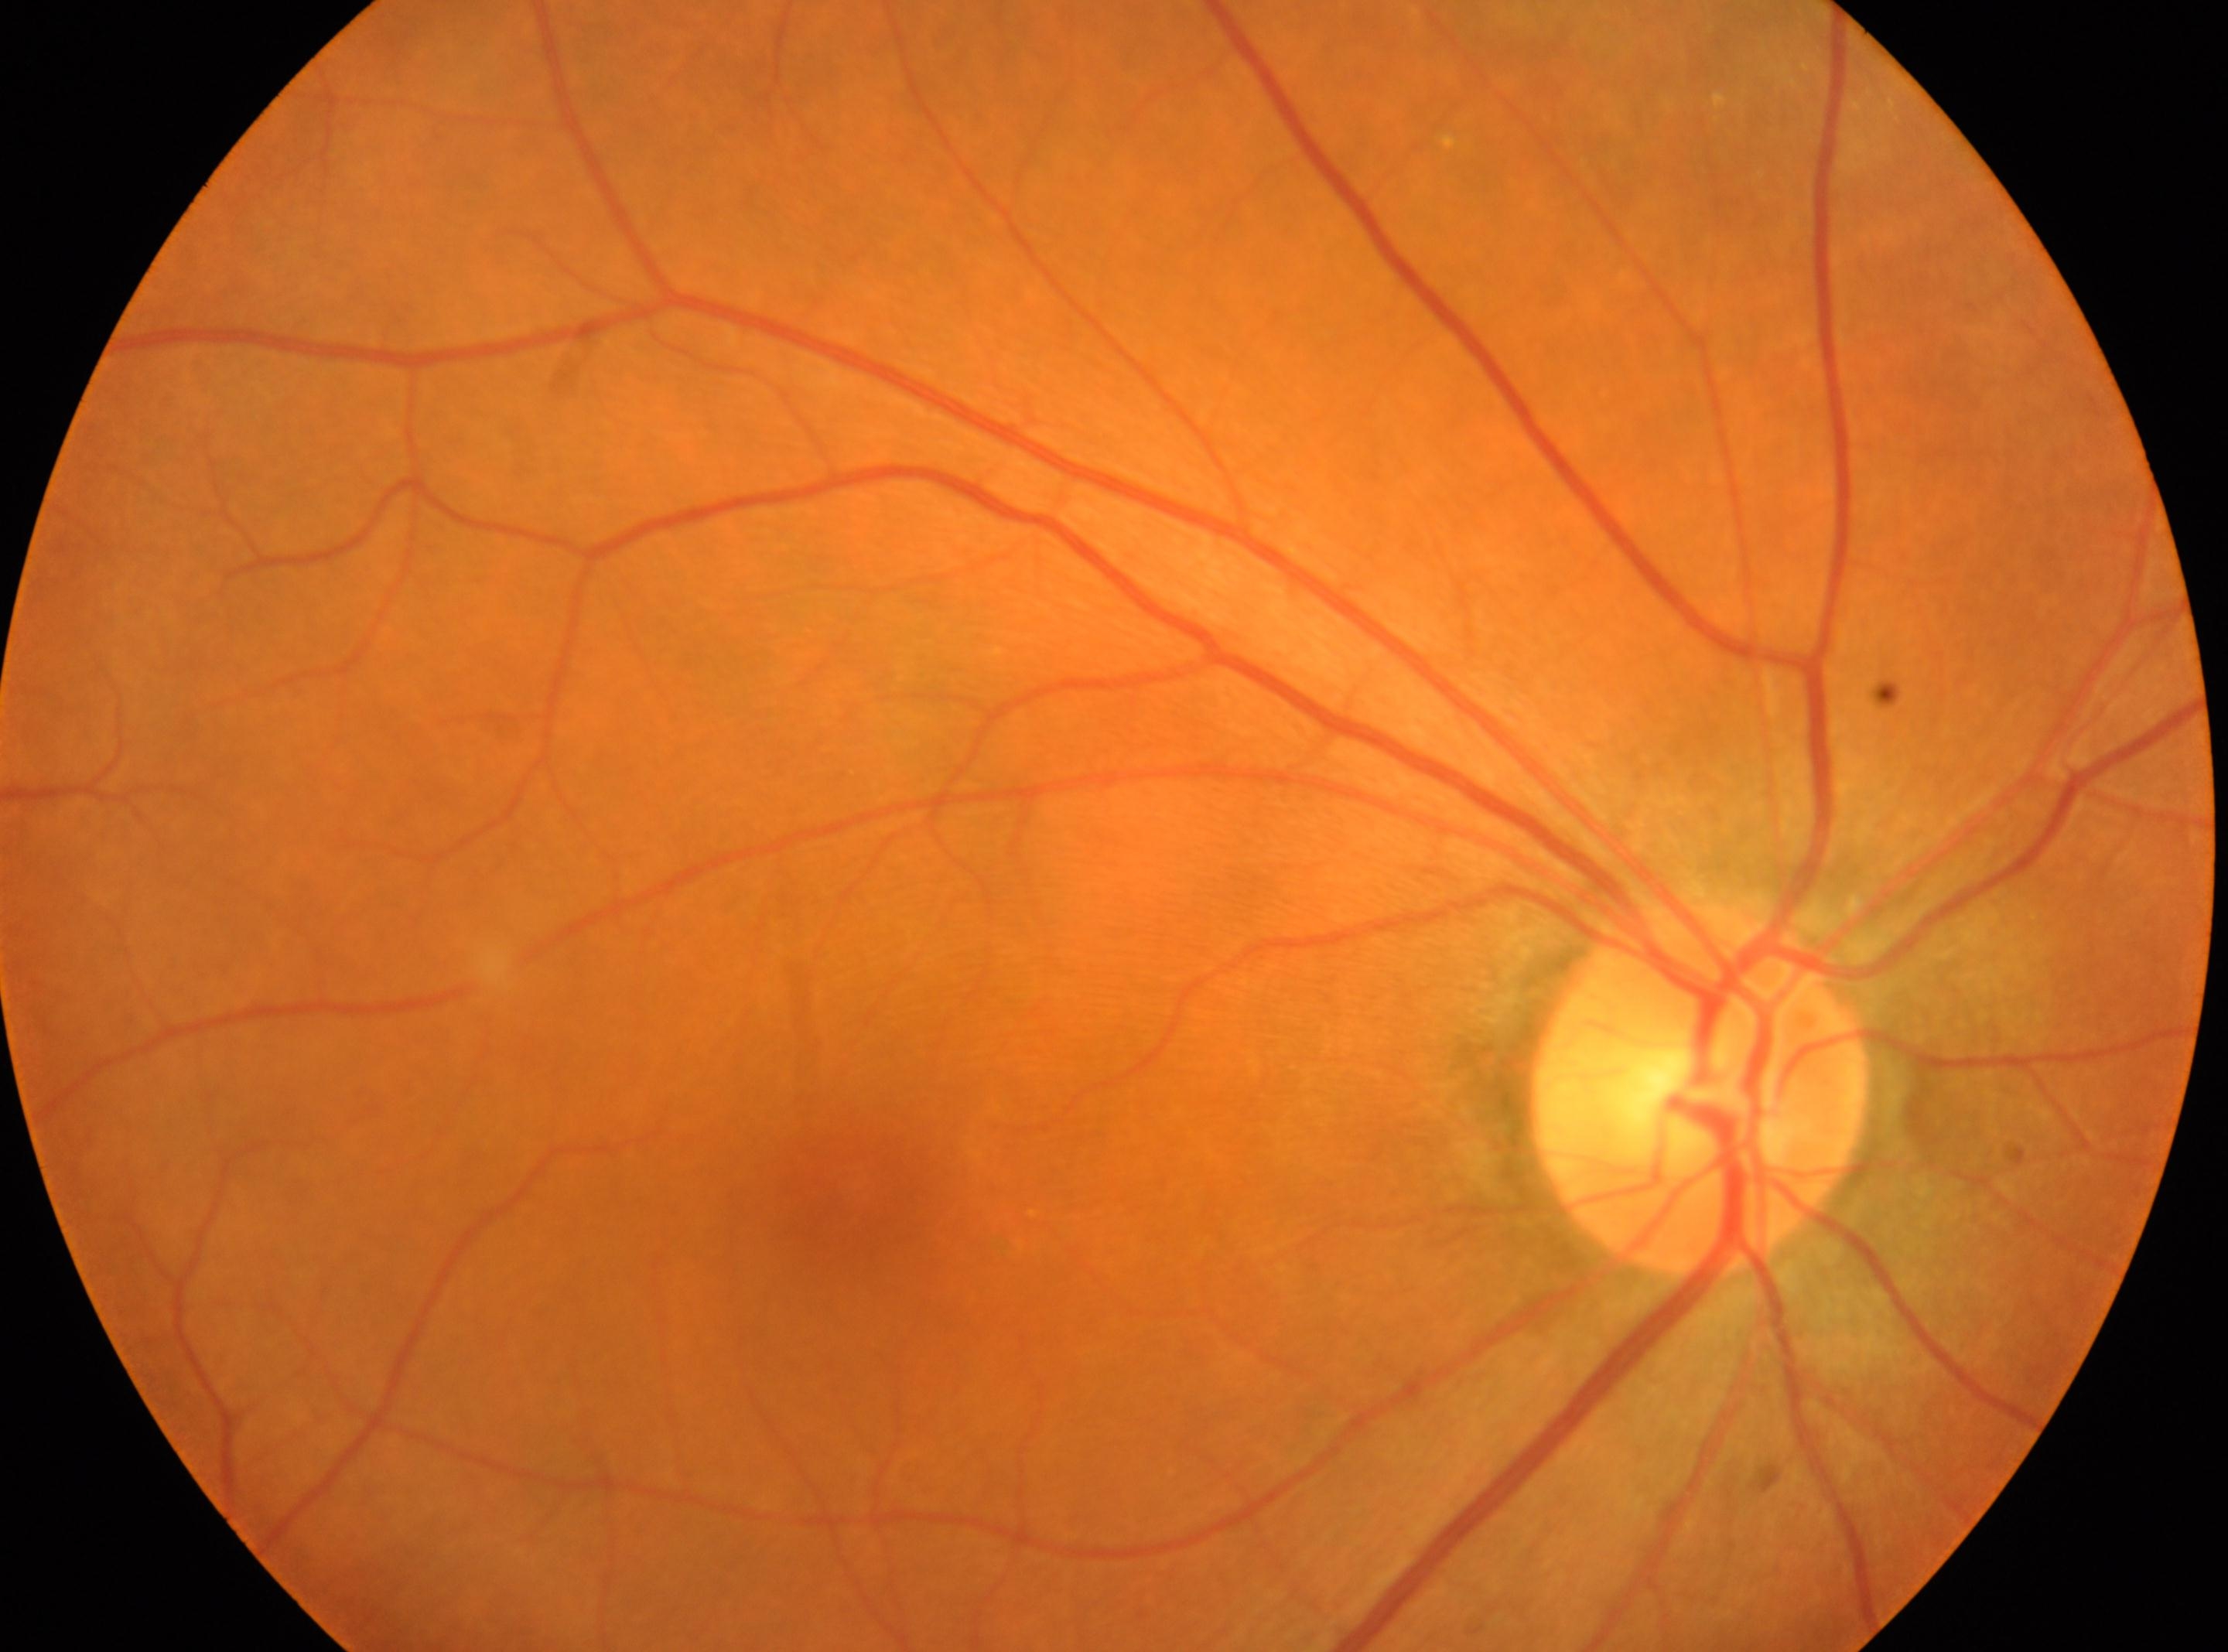 Q: Locate the optic disc.
A: (x=1700, y=1088)
Q: Where is the fovea?
A: (x=848, y=1199)
Q: What is the laterality?
A: oculus dexter
Q: What is the DR grade?
A: grade 0